Camera: Phoenix ICON (100° FOV). Phoenix ICON wide-field infant fundus image. 1240 x 1240 pixels:
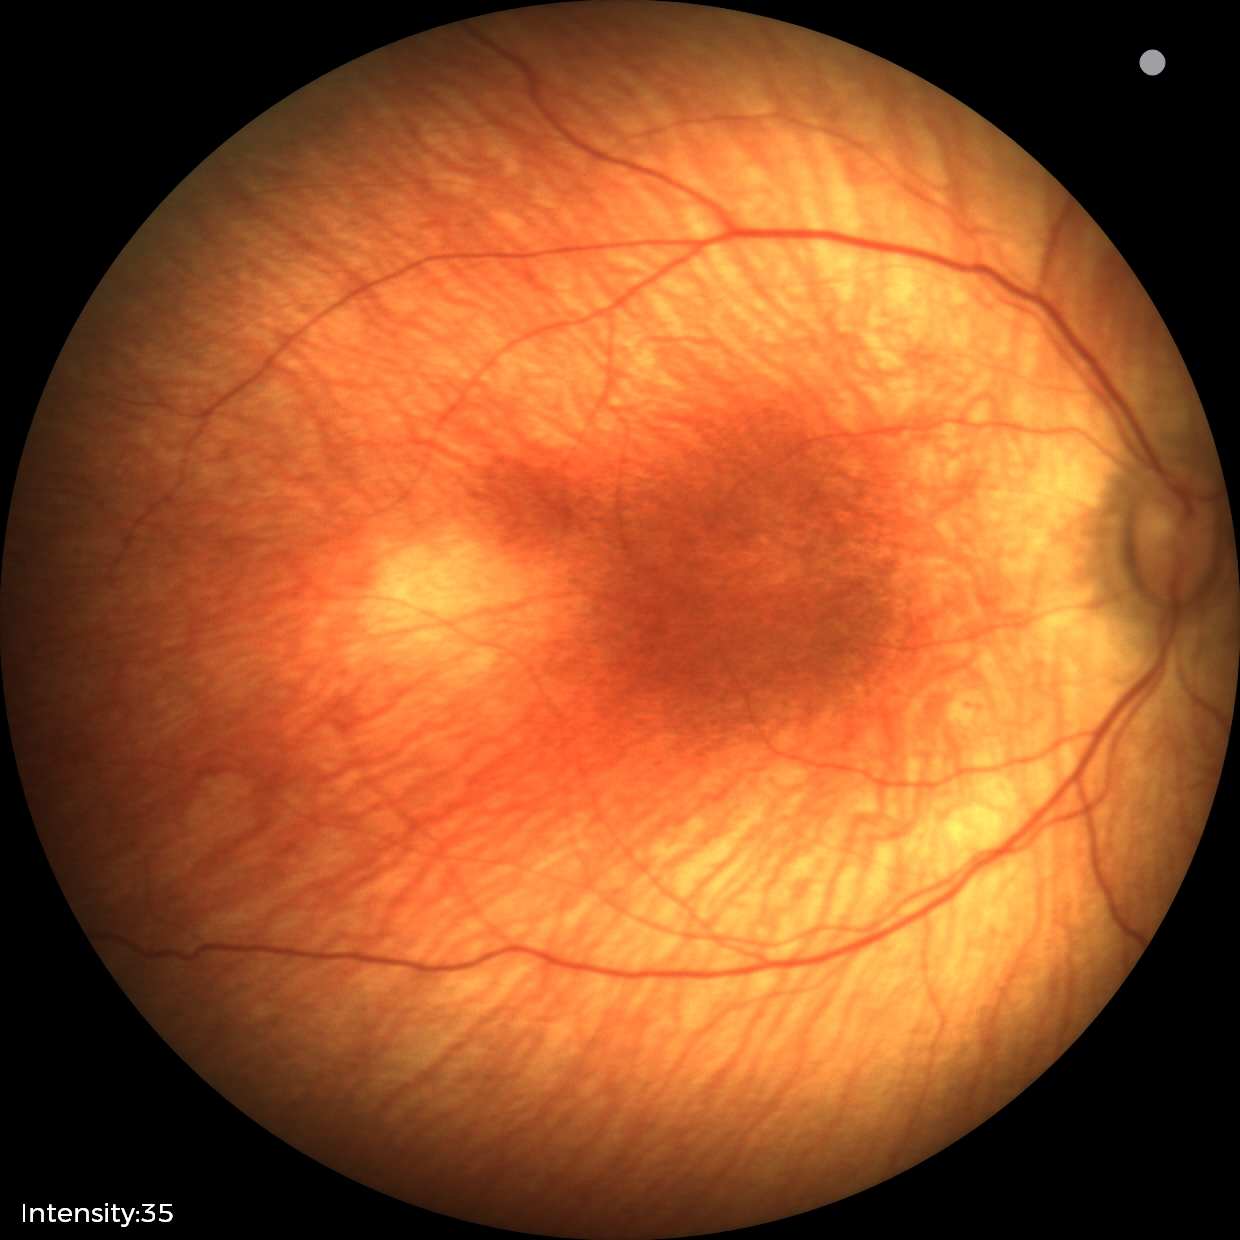
Diagnosis from this screening exam: status post ROP. No plus disease.